Pediatric retinal photograph (wide-field) · 640x480 — 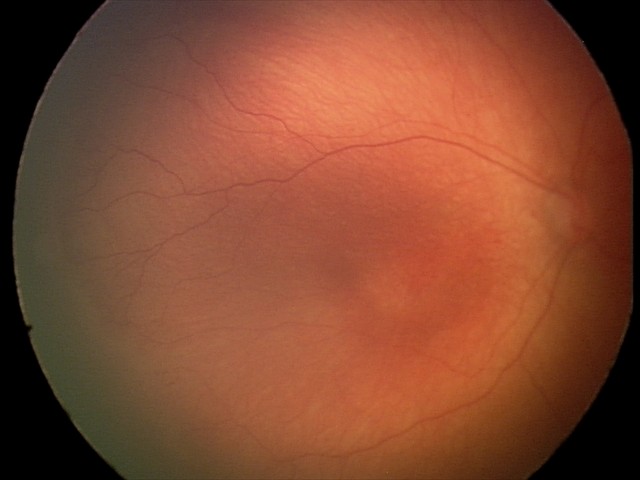 Diagnosis from this screening exam: ROP stage 1.